Camera: Phoenix ICON (100° FOV) · wide-field fundus photograph from neonatal ROP screening
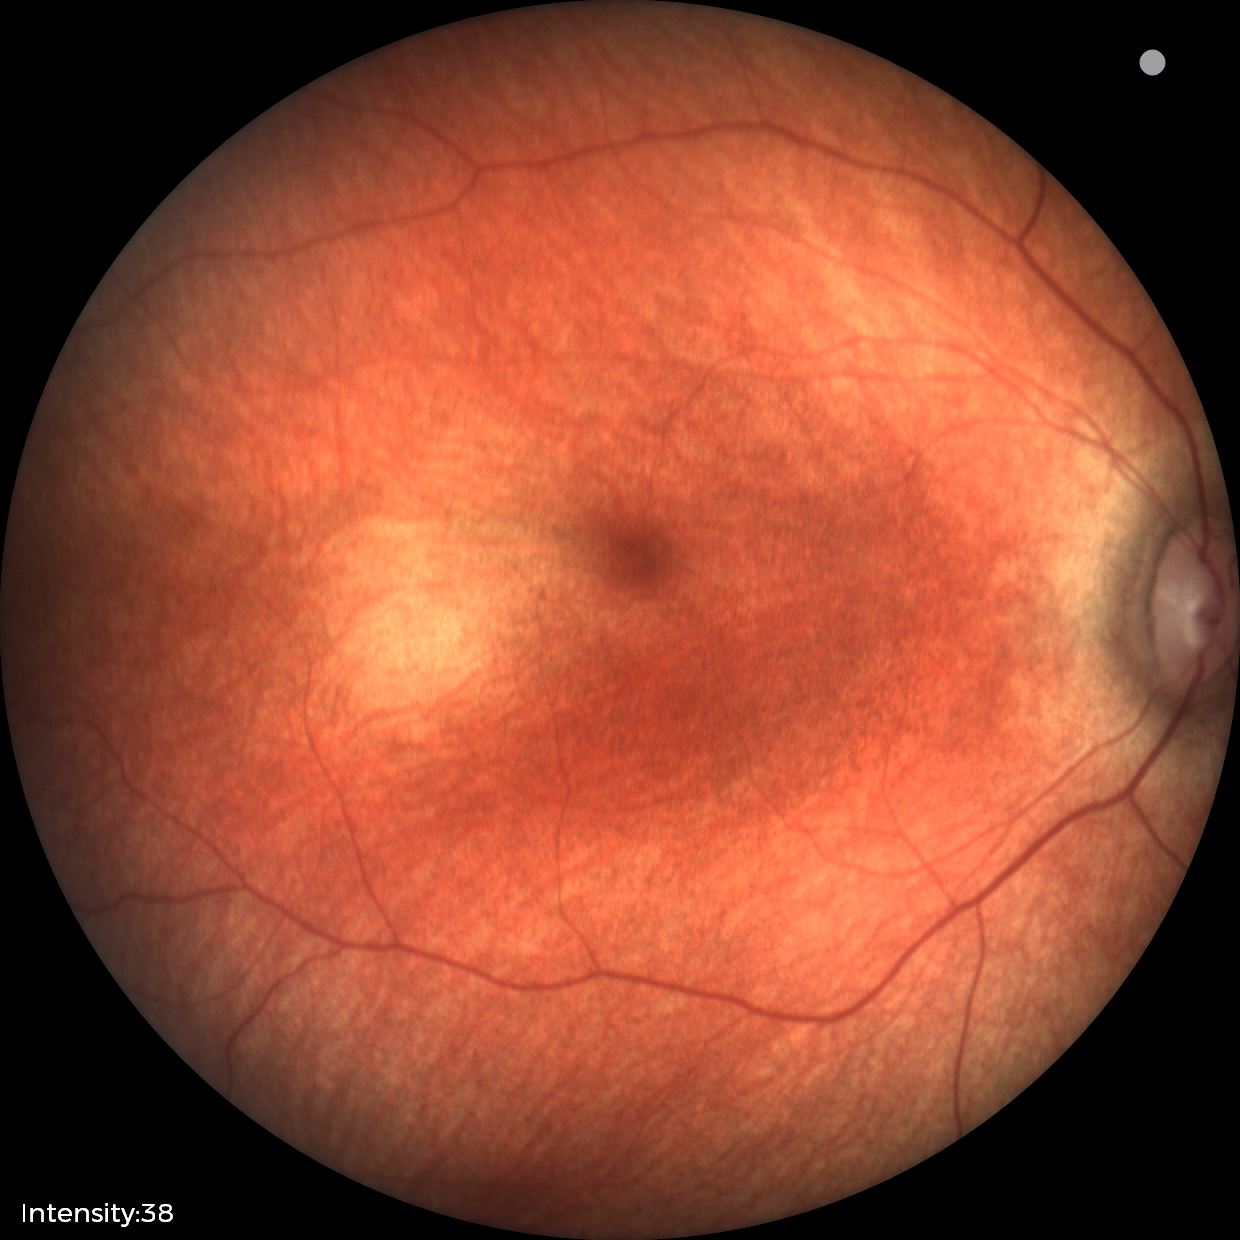 Assessment: physiological appearance with no retinal pathology.